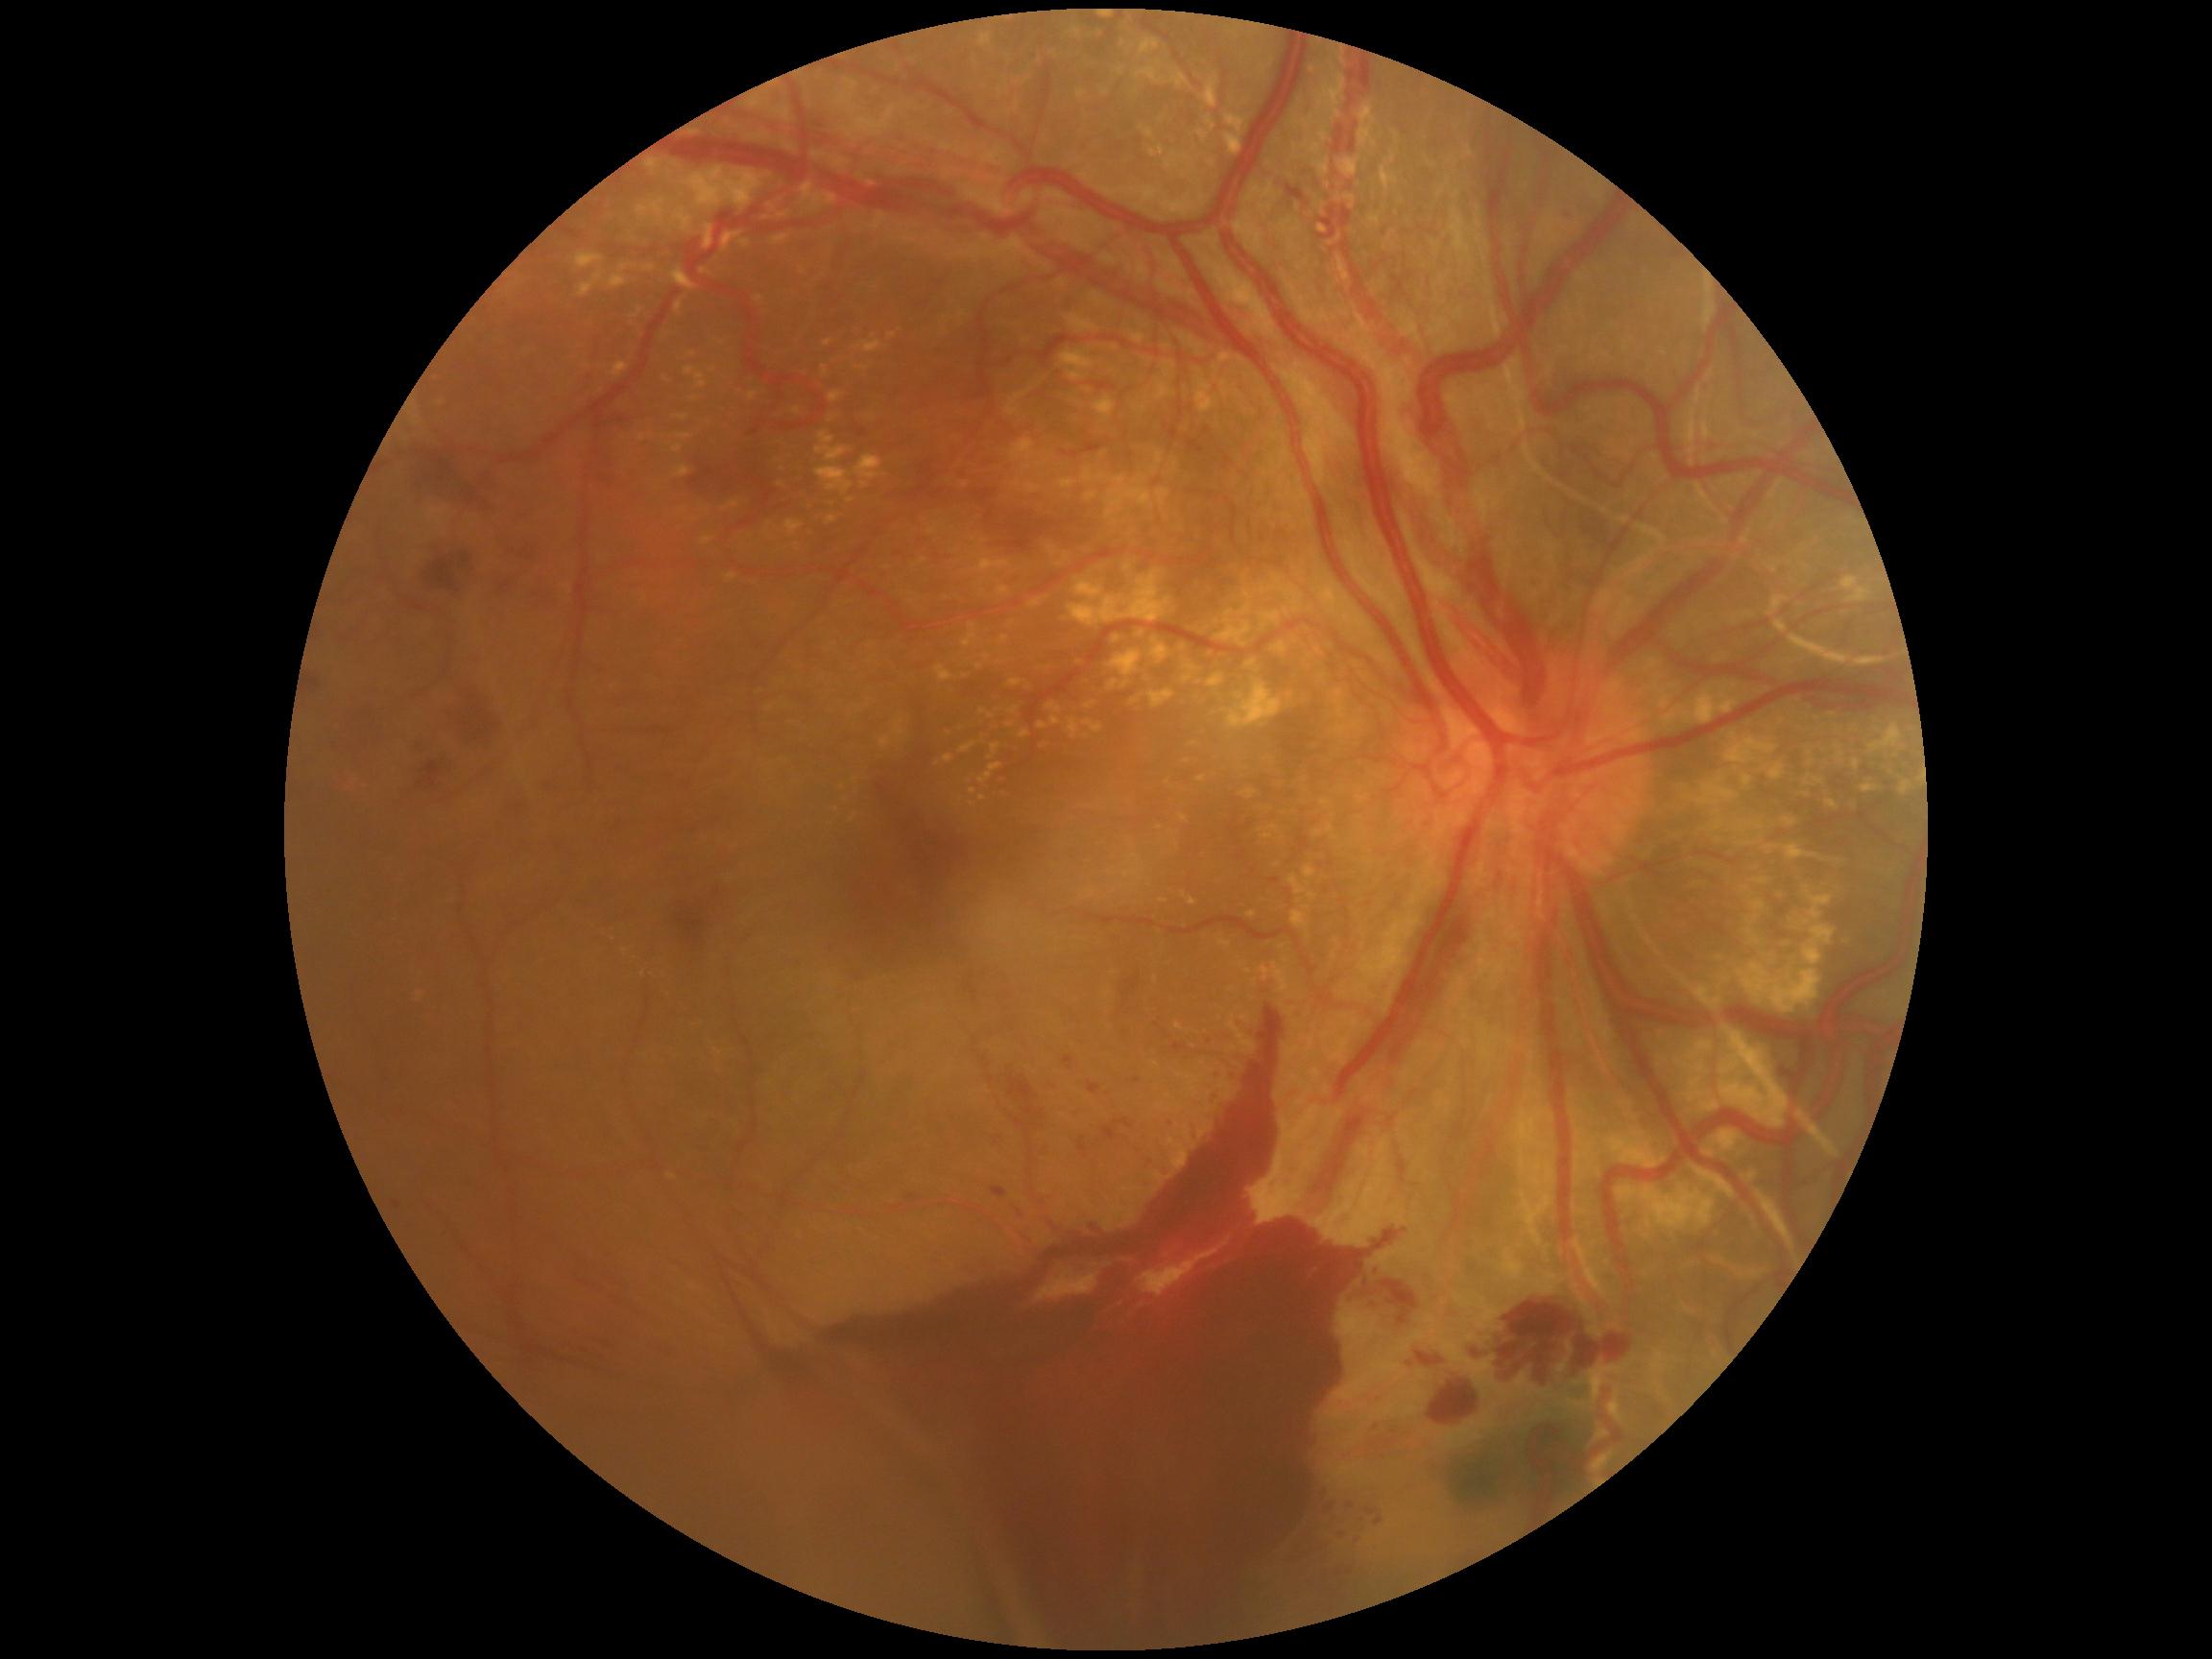
DR severity is grade 4 (PDR).